45° field of view. Diabetic retinopathy graded by the modified Davis classification. No pharmacologic dilation
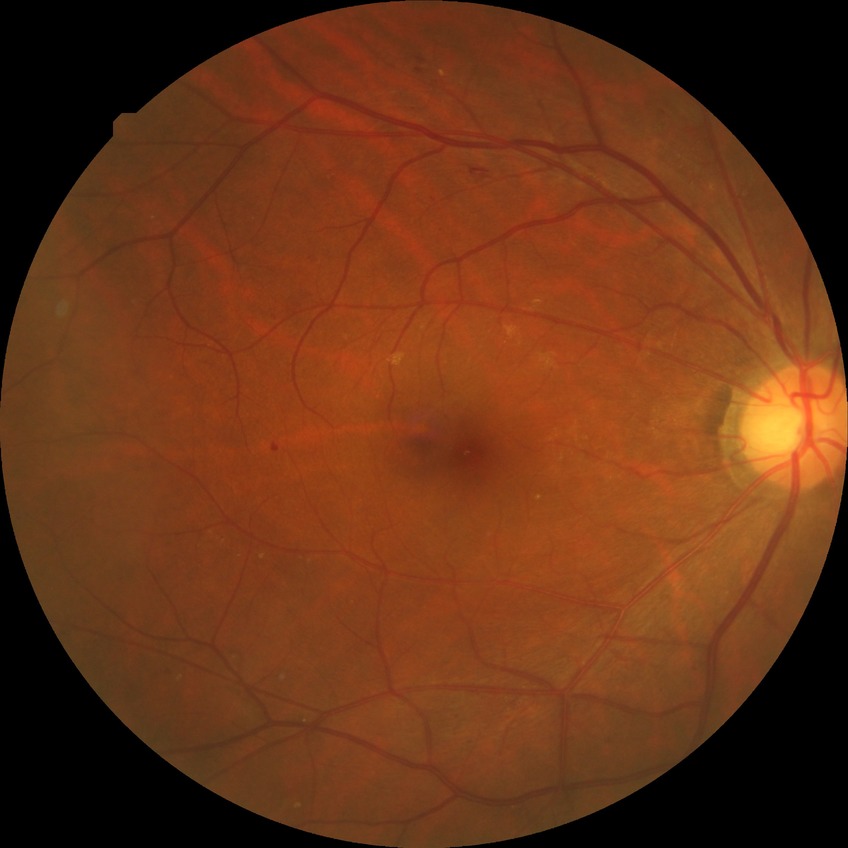

{
  "davis_grade": "simple diabetic retinopathy"
}